Modified Davis grading.
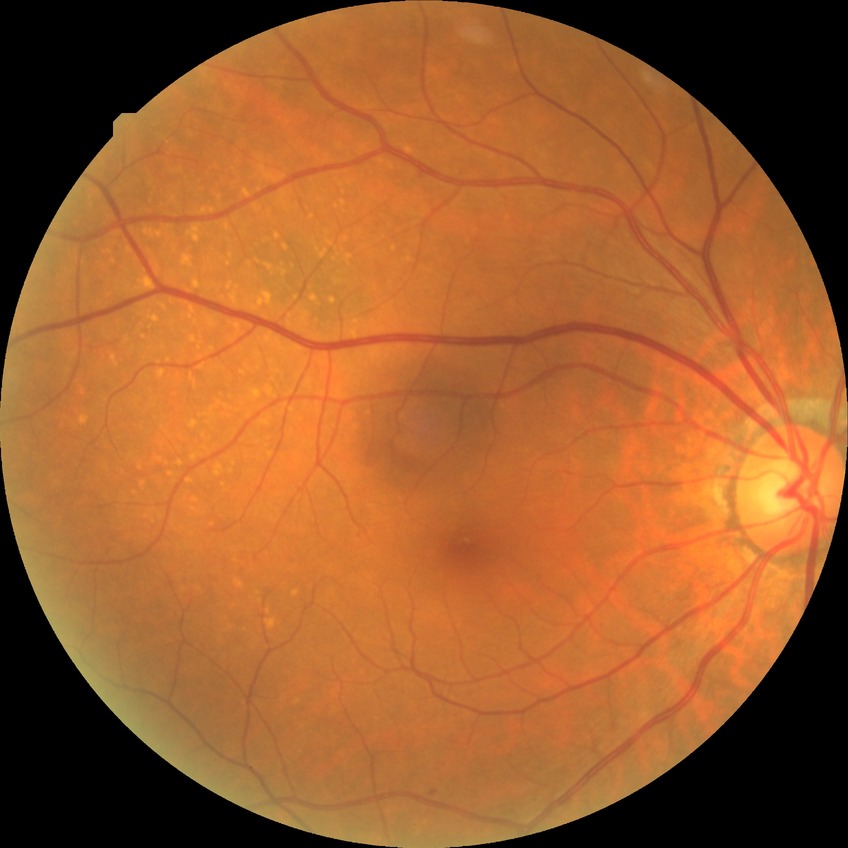

Annotations:
- modified Davis grading — simple diabetic retinopathy